2352 x 1568 pixels
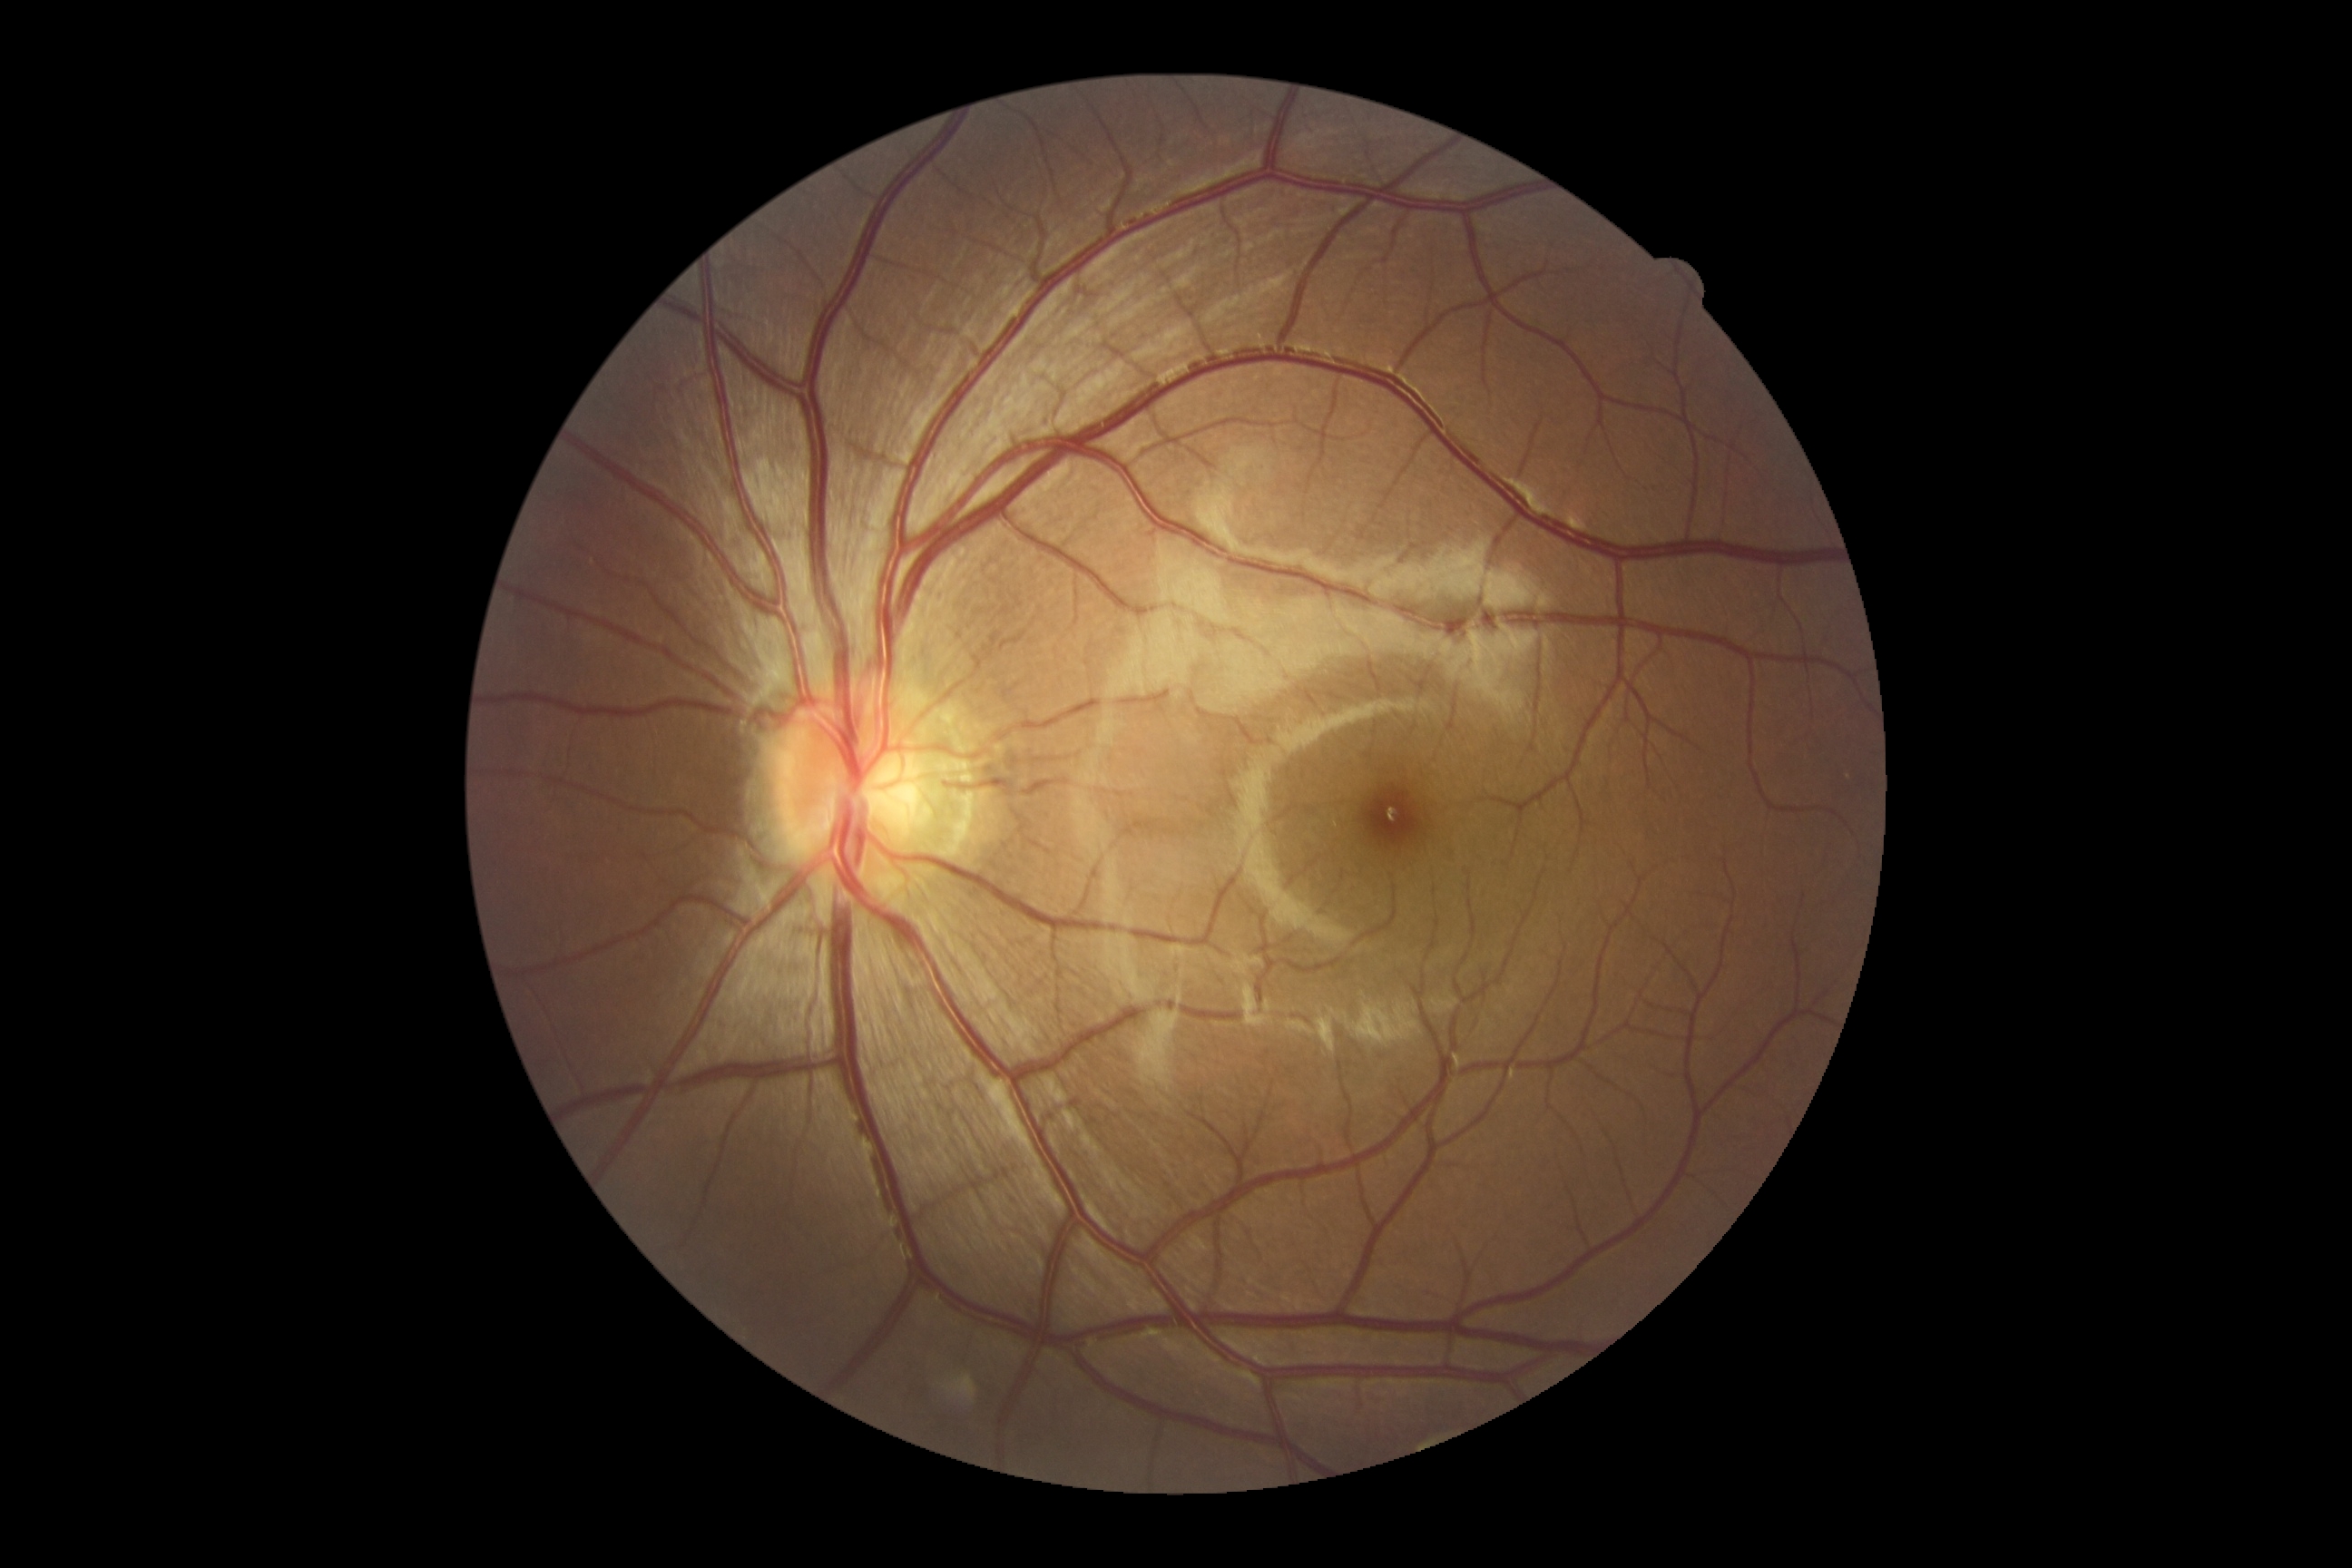
DR severity: grade 0 (no apparent retinopathy).